Infant wide-field fundus photograph:
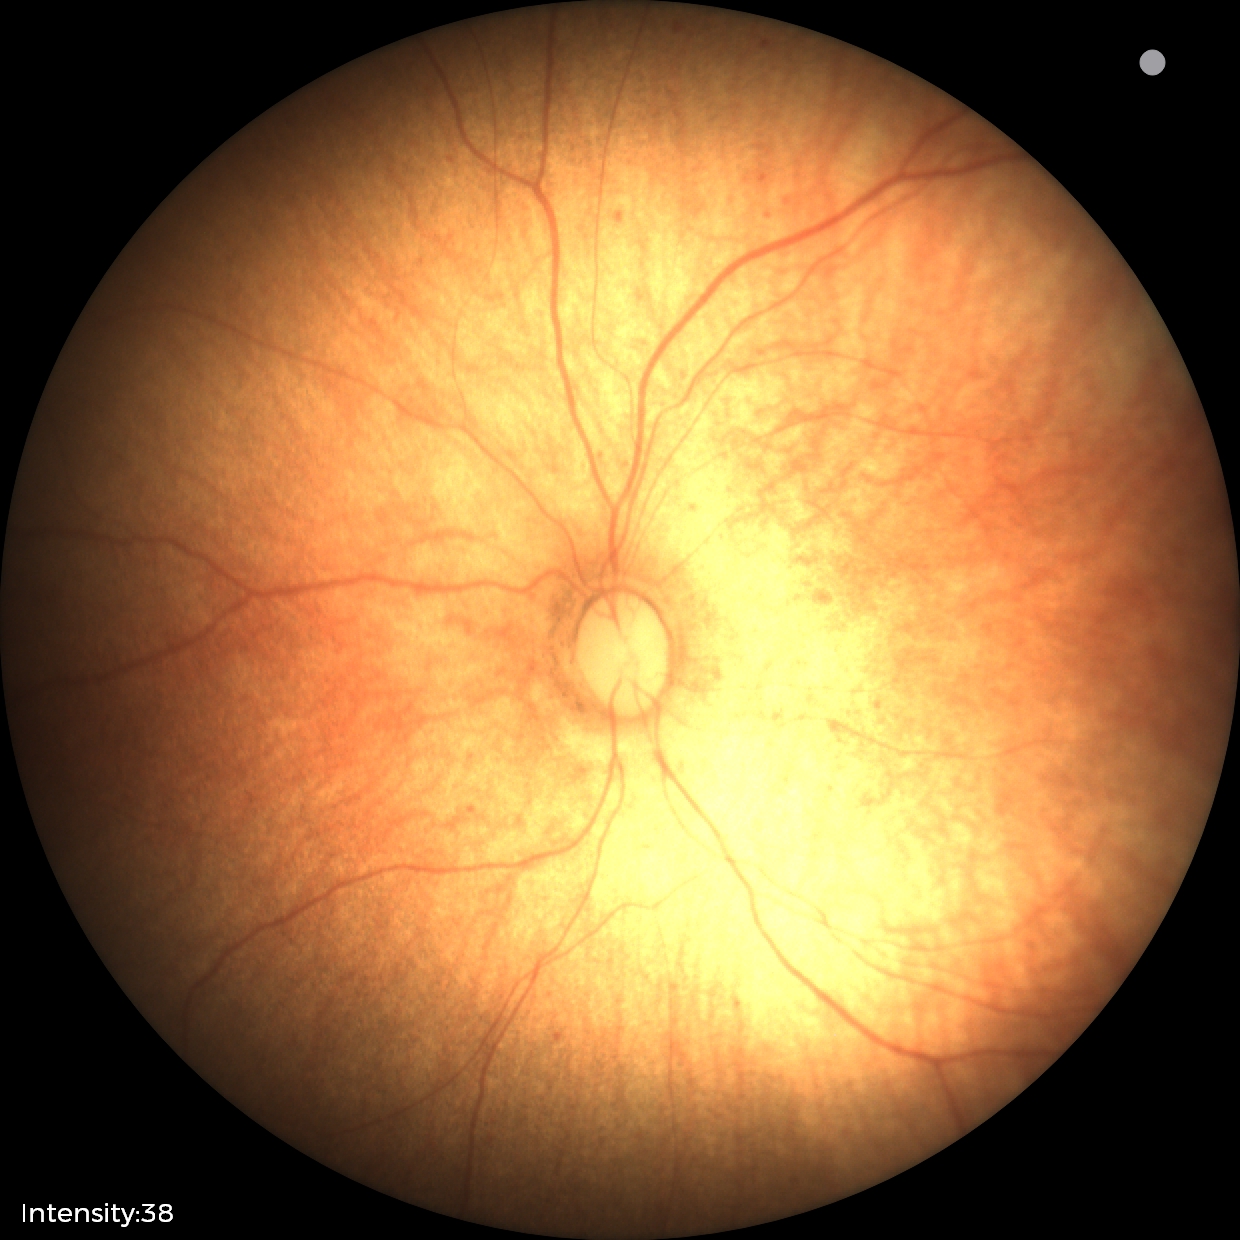

Impression = normal.